Fundus photo. Acquired with a NIDEK AFC-230. Image size 848x848 — 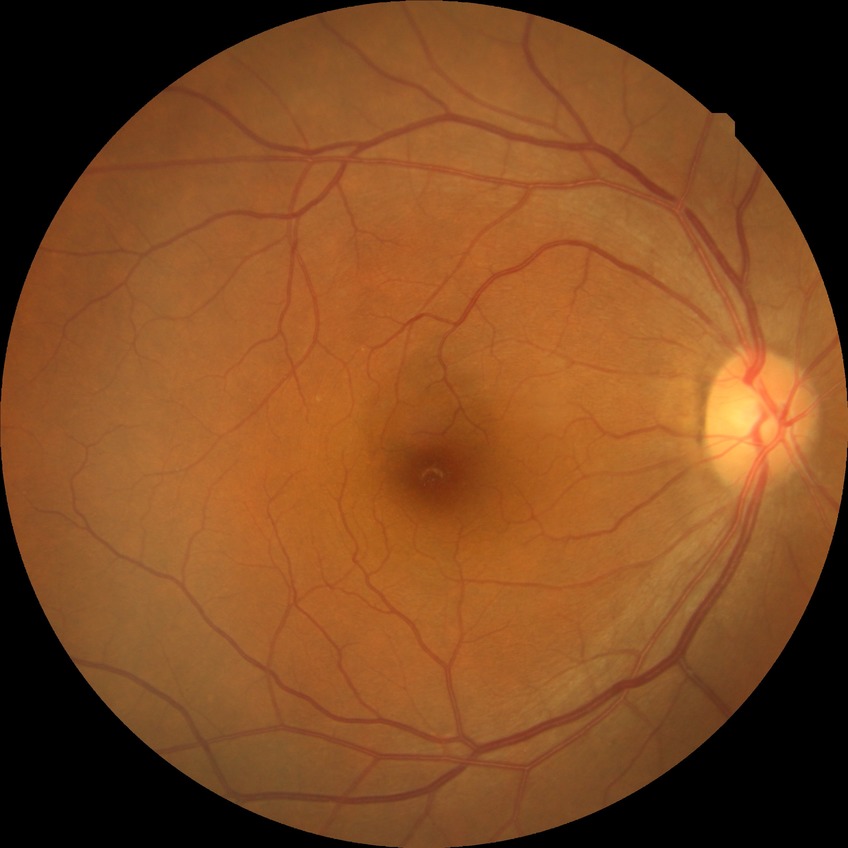
Modified Davis grade: NDR.